50-degree field of view. 1924x1556. Color fundus image.
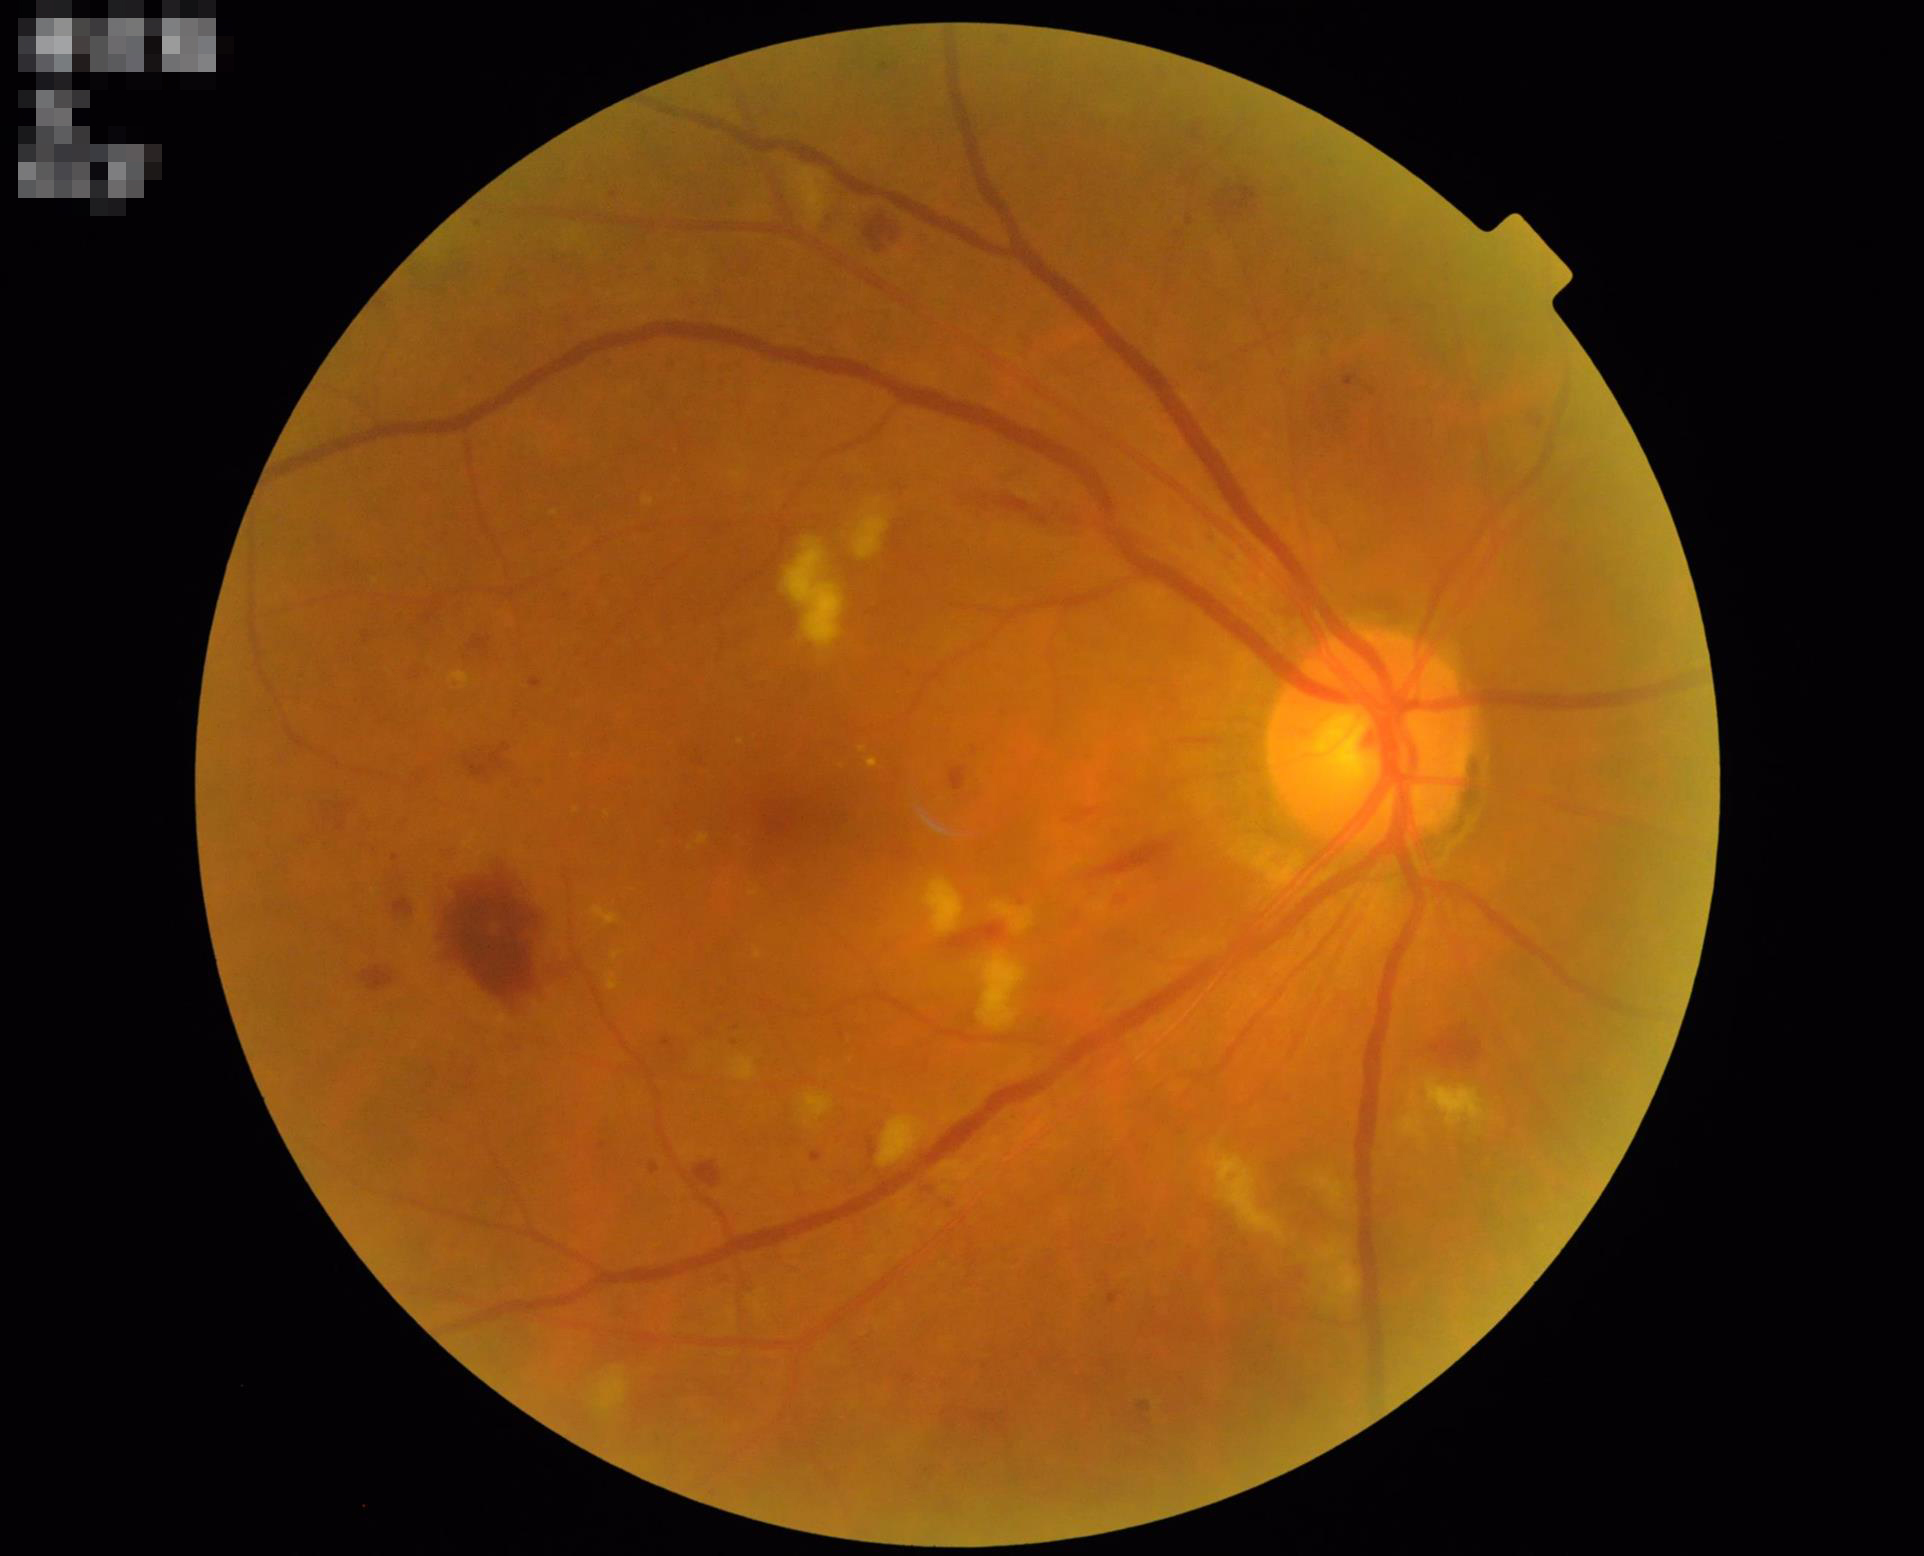
Quality grading: illumination: no over- or under-exposure; sharpness: clear with no noticeable blur; overall: good, gradable; contrast: vessels and details readily distinguishable.